Color fundus photograph · 2048x1536 — 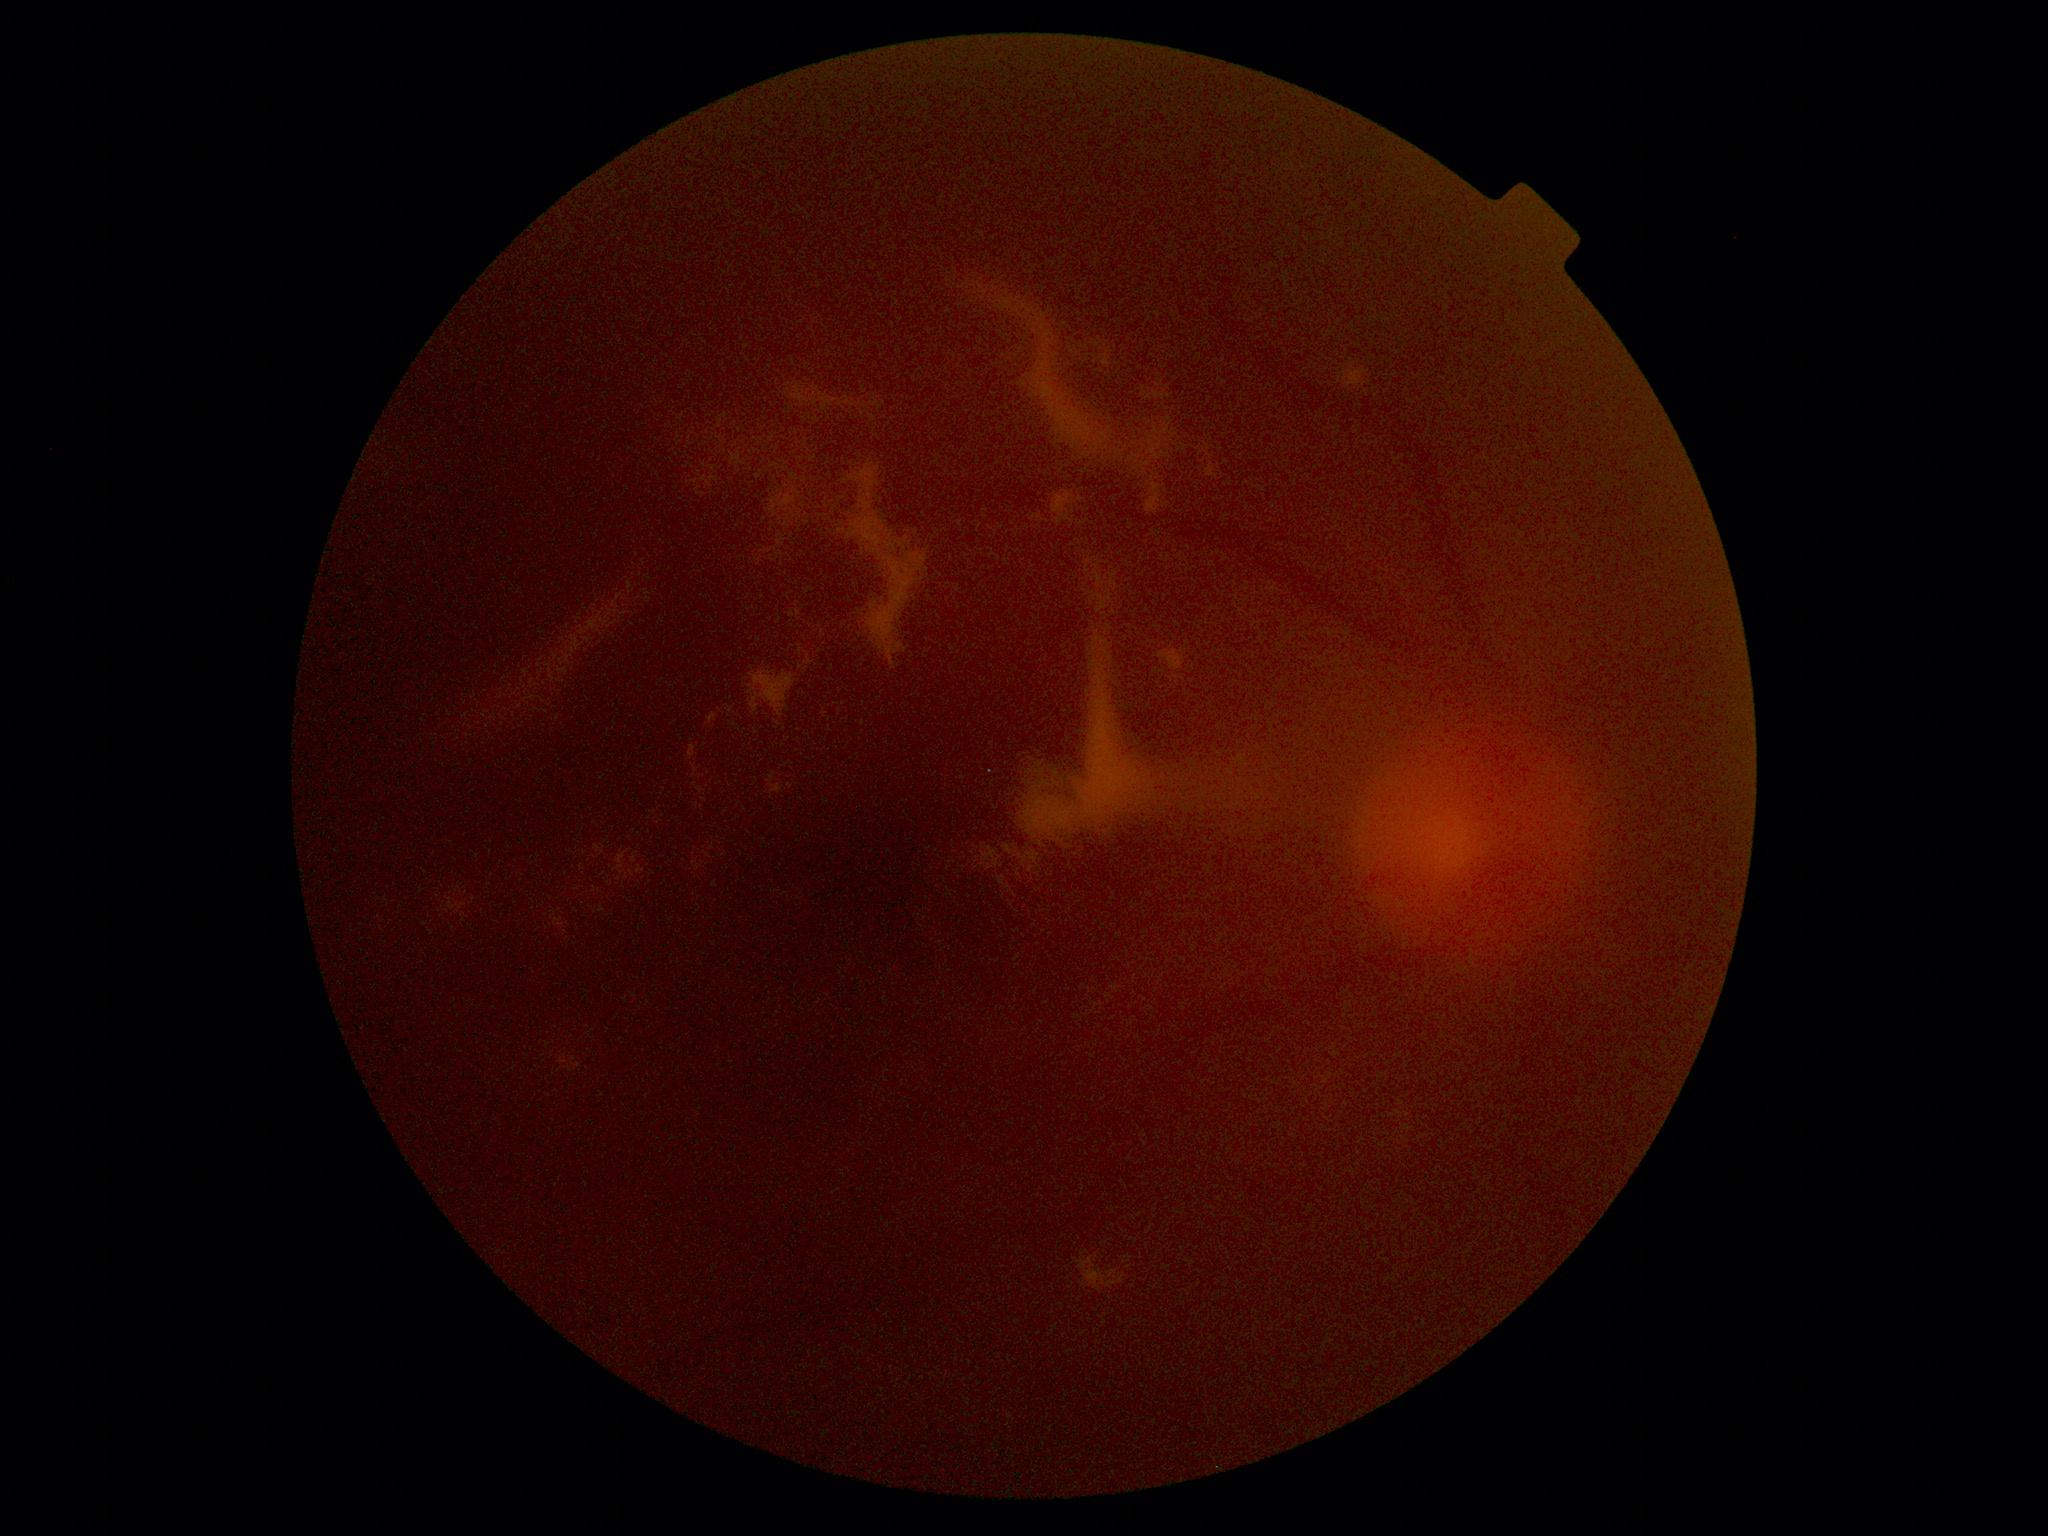
  dr_grade: ungradable due to poor image quality